2212 x 1661 pixels; sex: male; non-mydriatic; captured on a Topcon TRC-NW400 fundus camera.
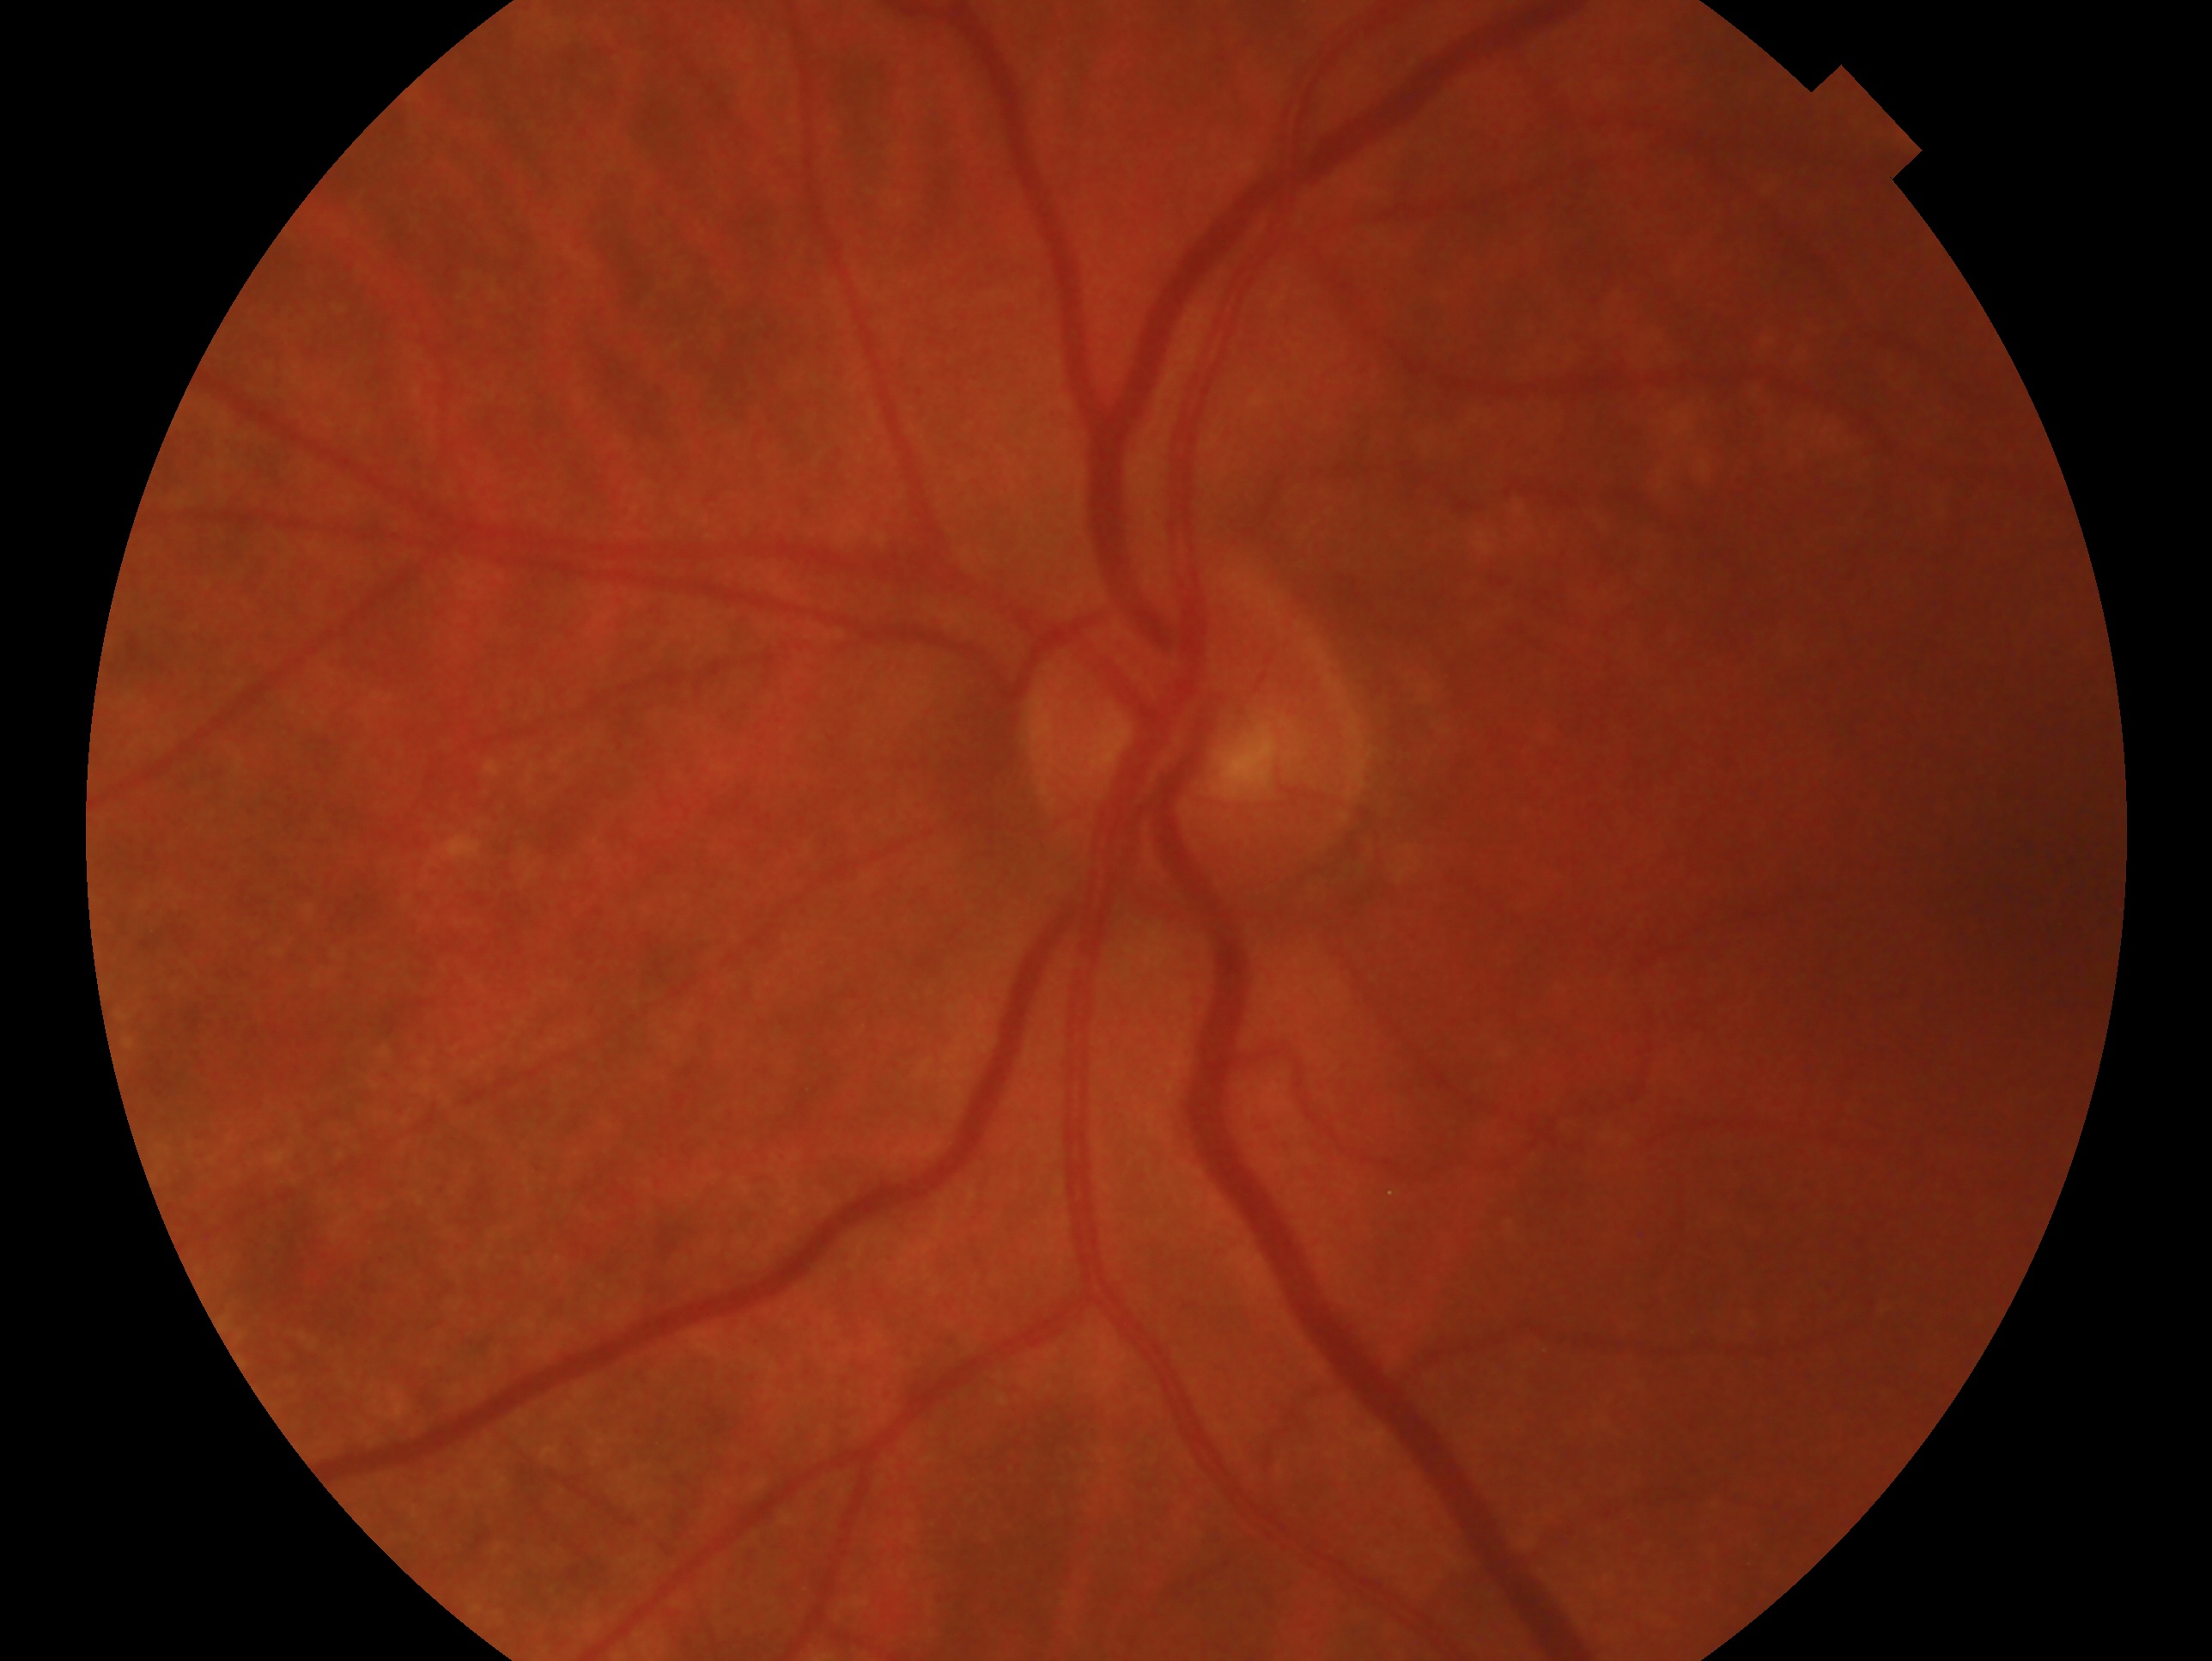

glaucoma status = no glaucoma
laterality = left